Tabletop color fundus camera image
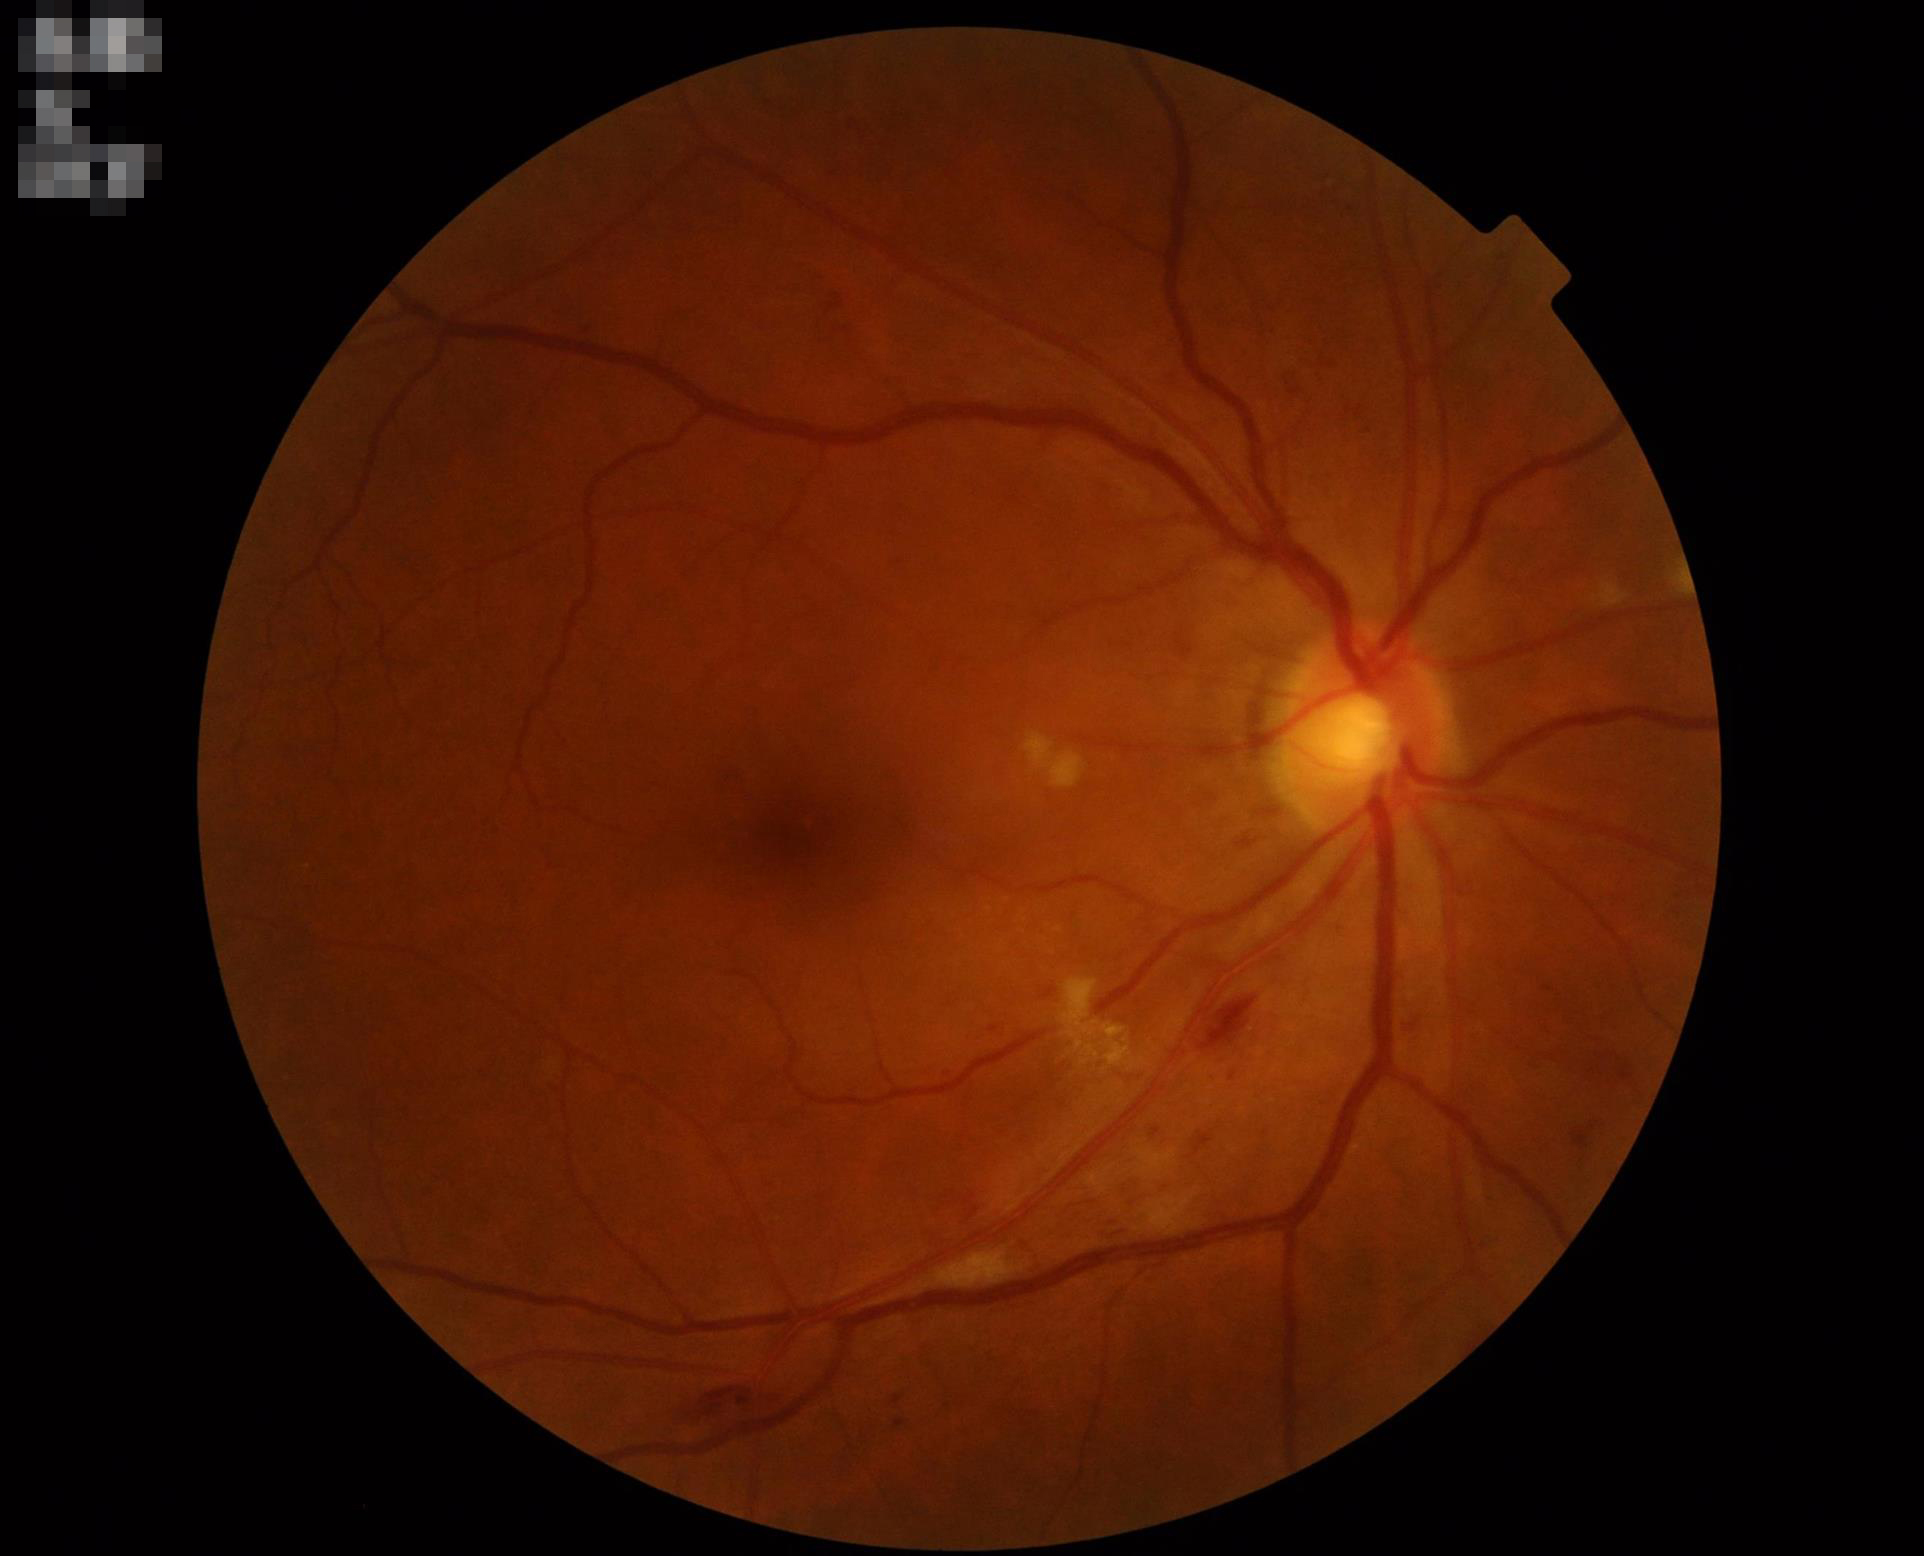
Contrast is good.
Overall quality is good and the image is gradable.
Optic disc, vessels, and background are in focus.
Even illumination with no color cast.